Wide-field fundus image from infant ROP screening — 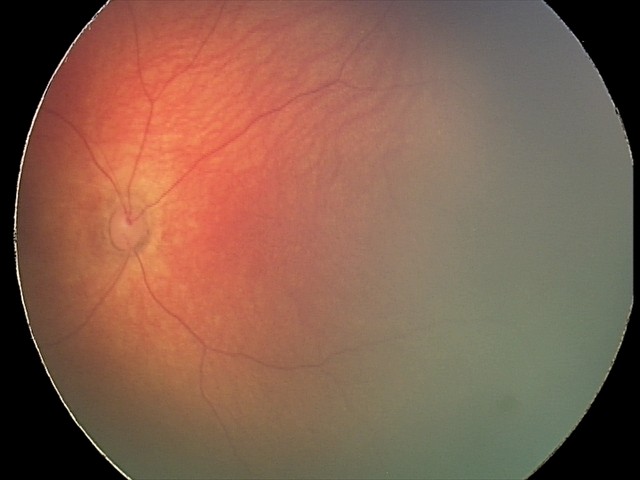
Screening examination consistent with retinal hemorrhages.